130° field of view (Clarity RetCam 3). Image size 640x480. RetCam wide-field infant fundus image: 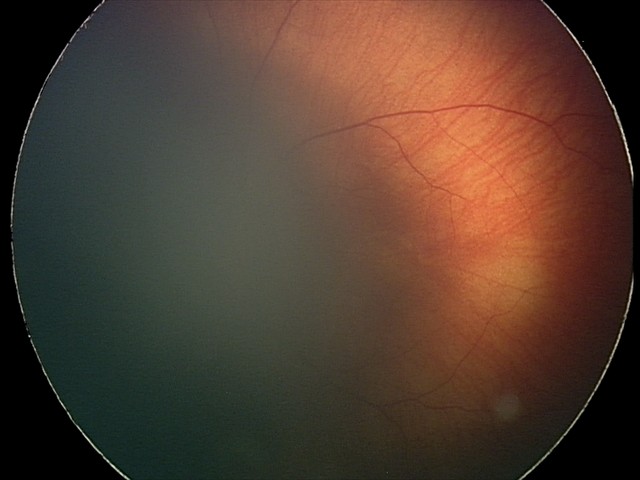 Screening series with retinal hemorrhages.